45-degree field of view; 2048x1536
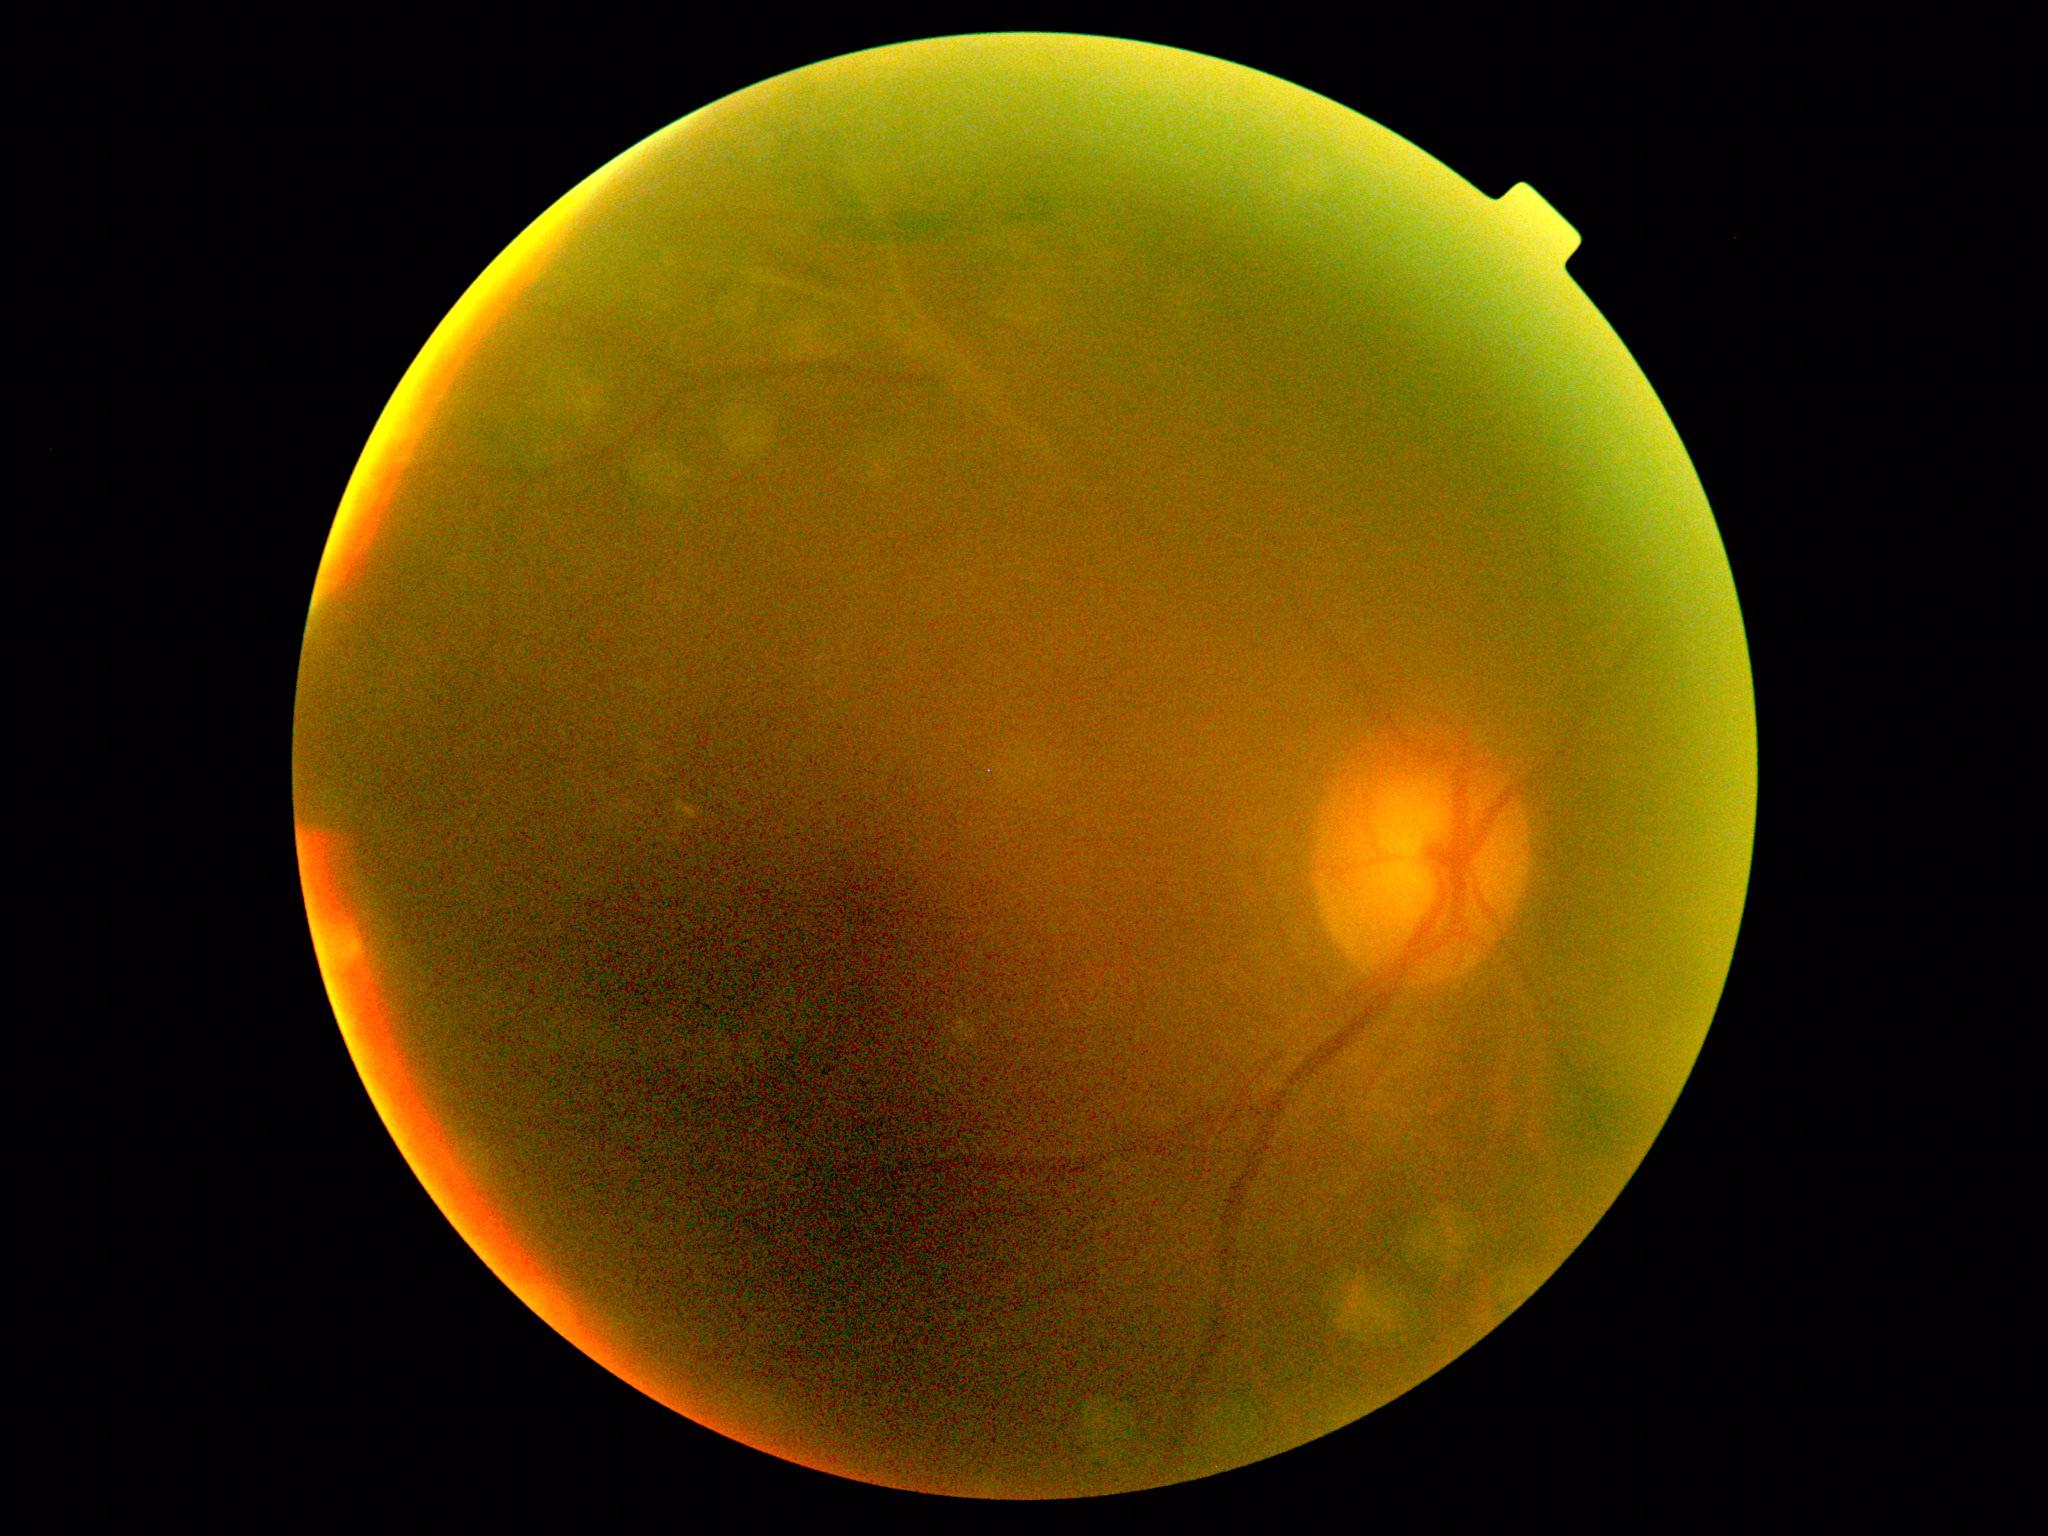 Diabetic retinopathy (DR) is grade 2 (moderate NPDR).